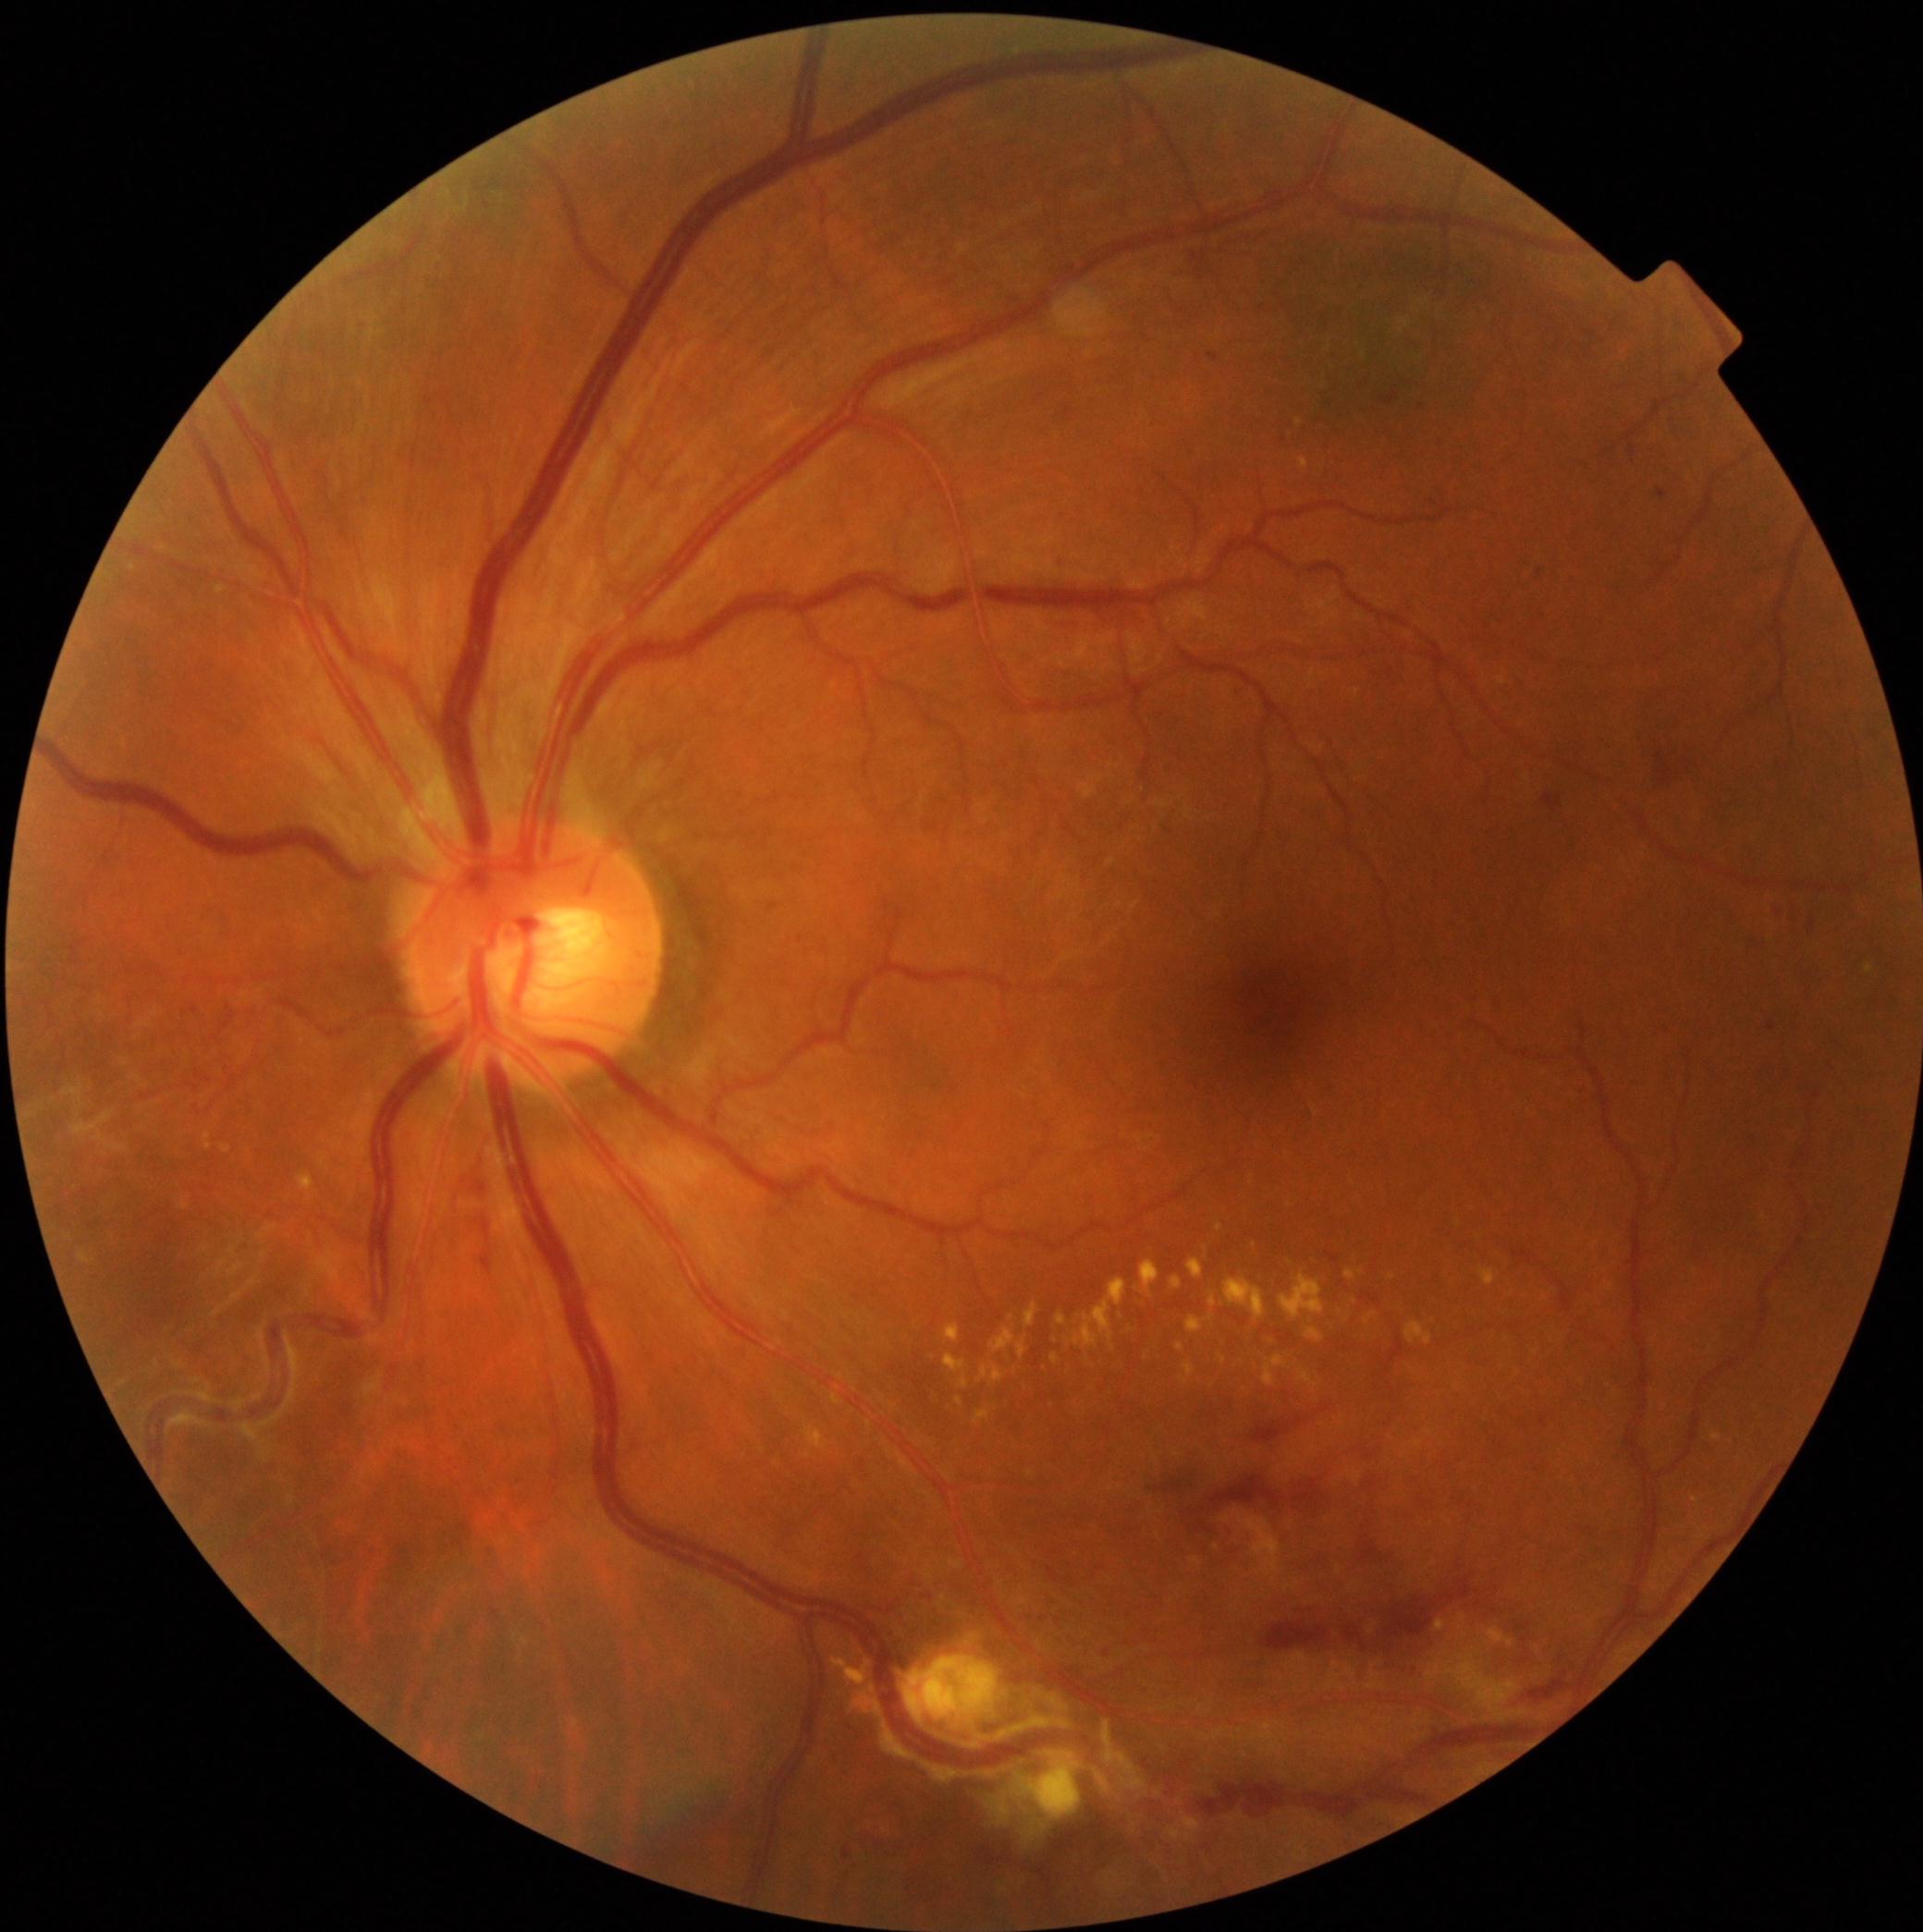
  dr_grade: 2 — more than just microaneurysms but less than severe NPDR